Image size 2212x1659, 45° FOV:
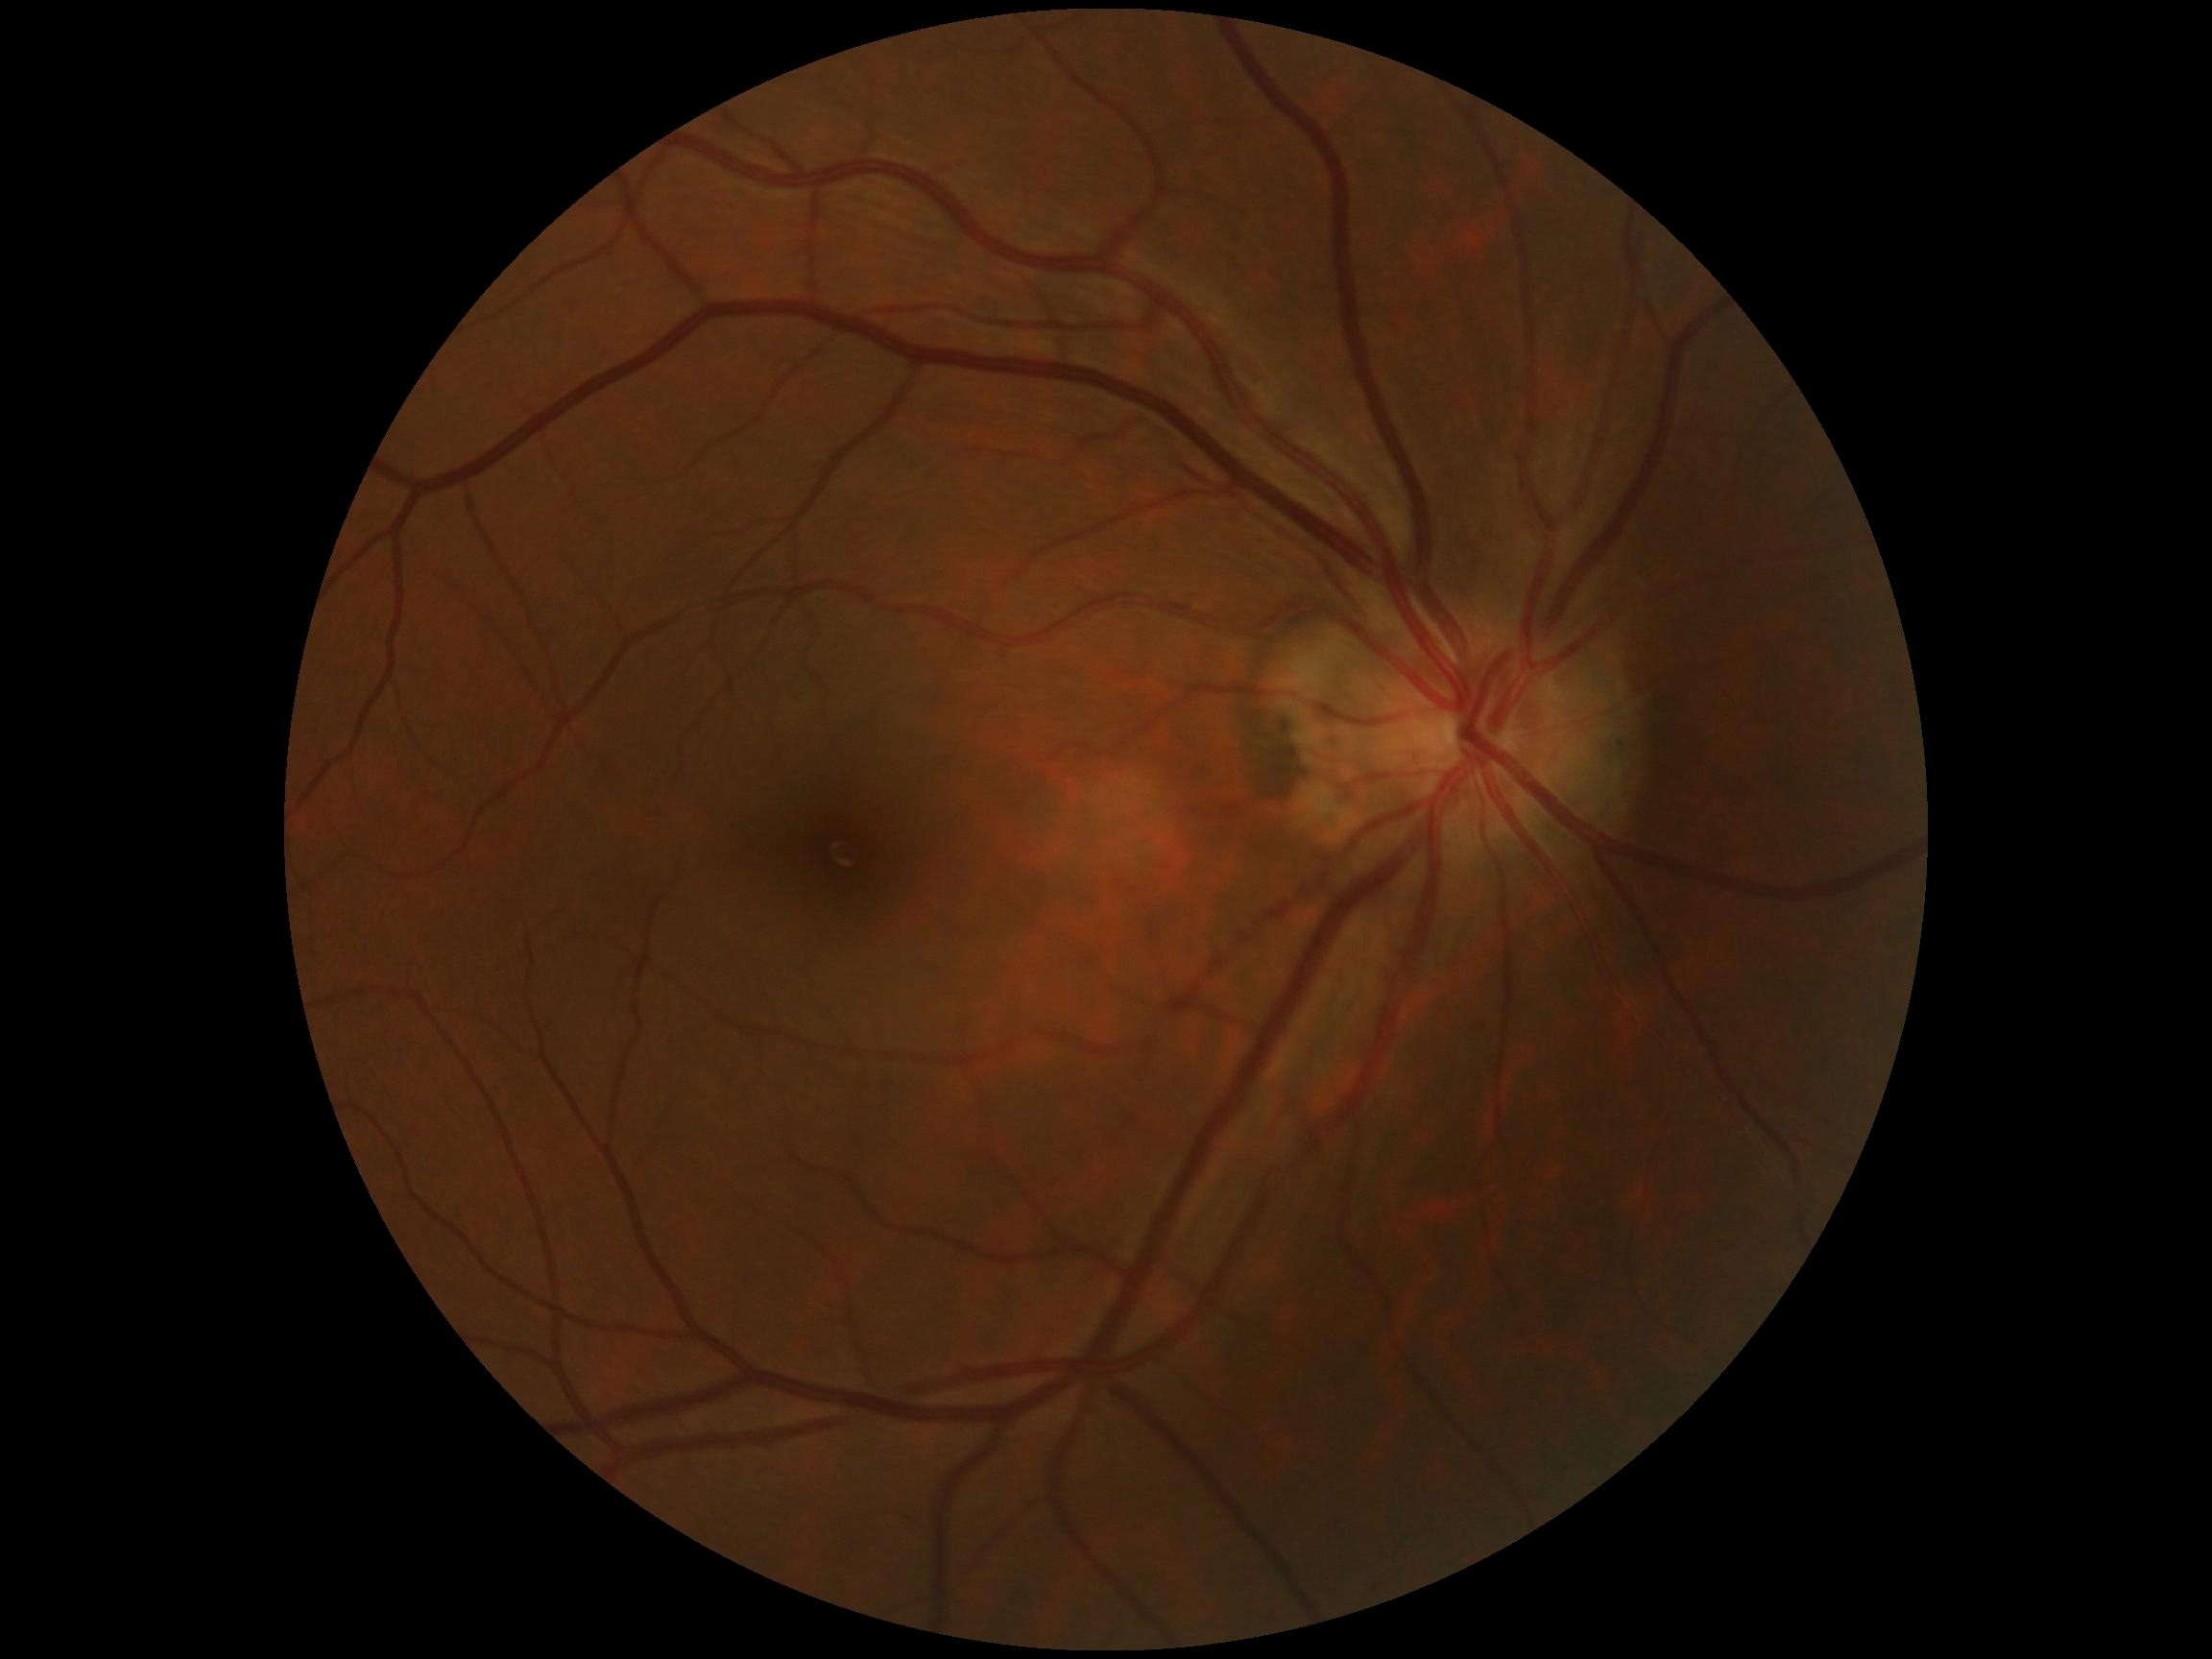

retinopathy grade=0.